Fundus photo
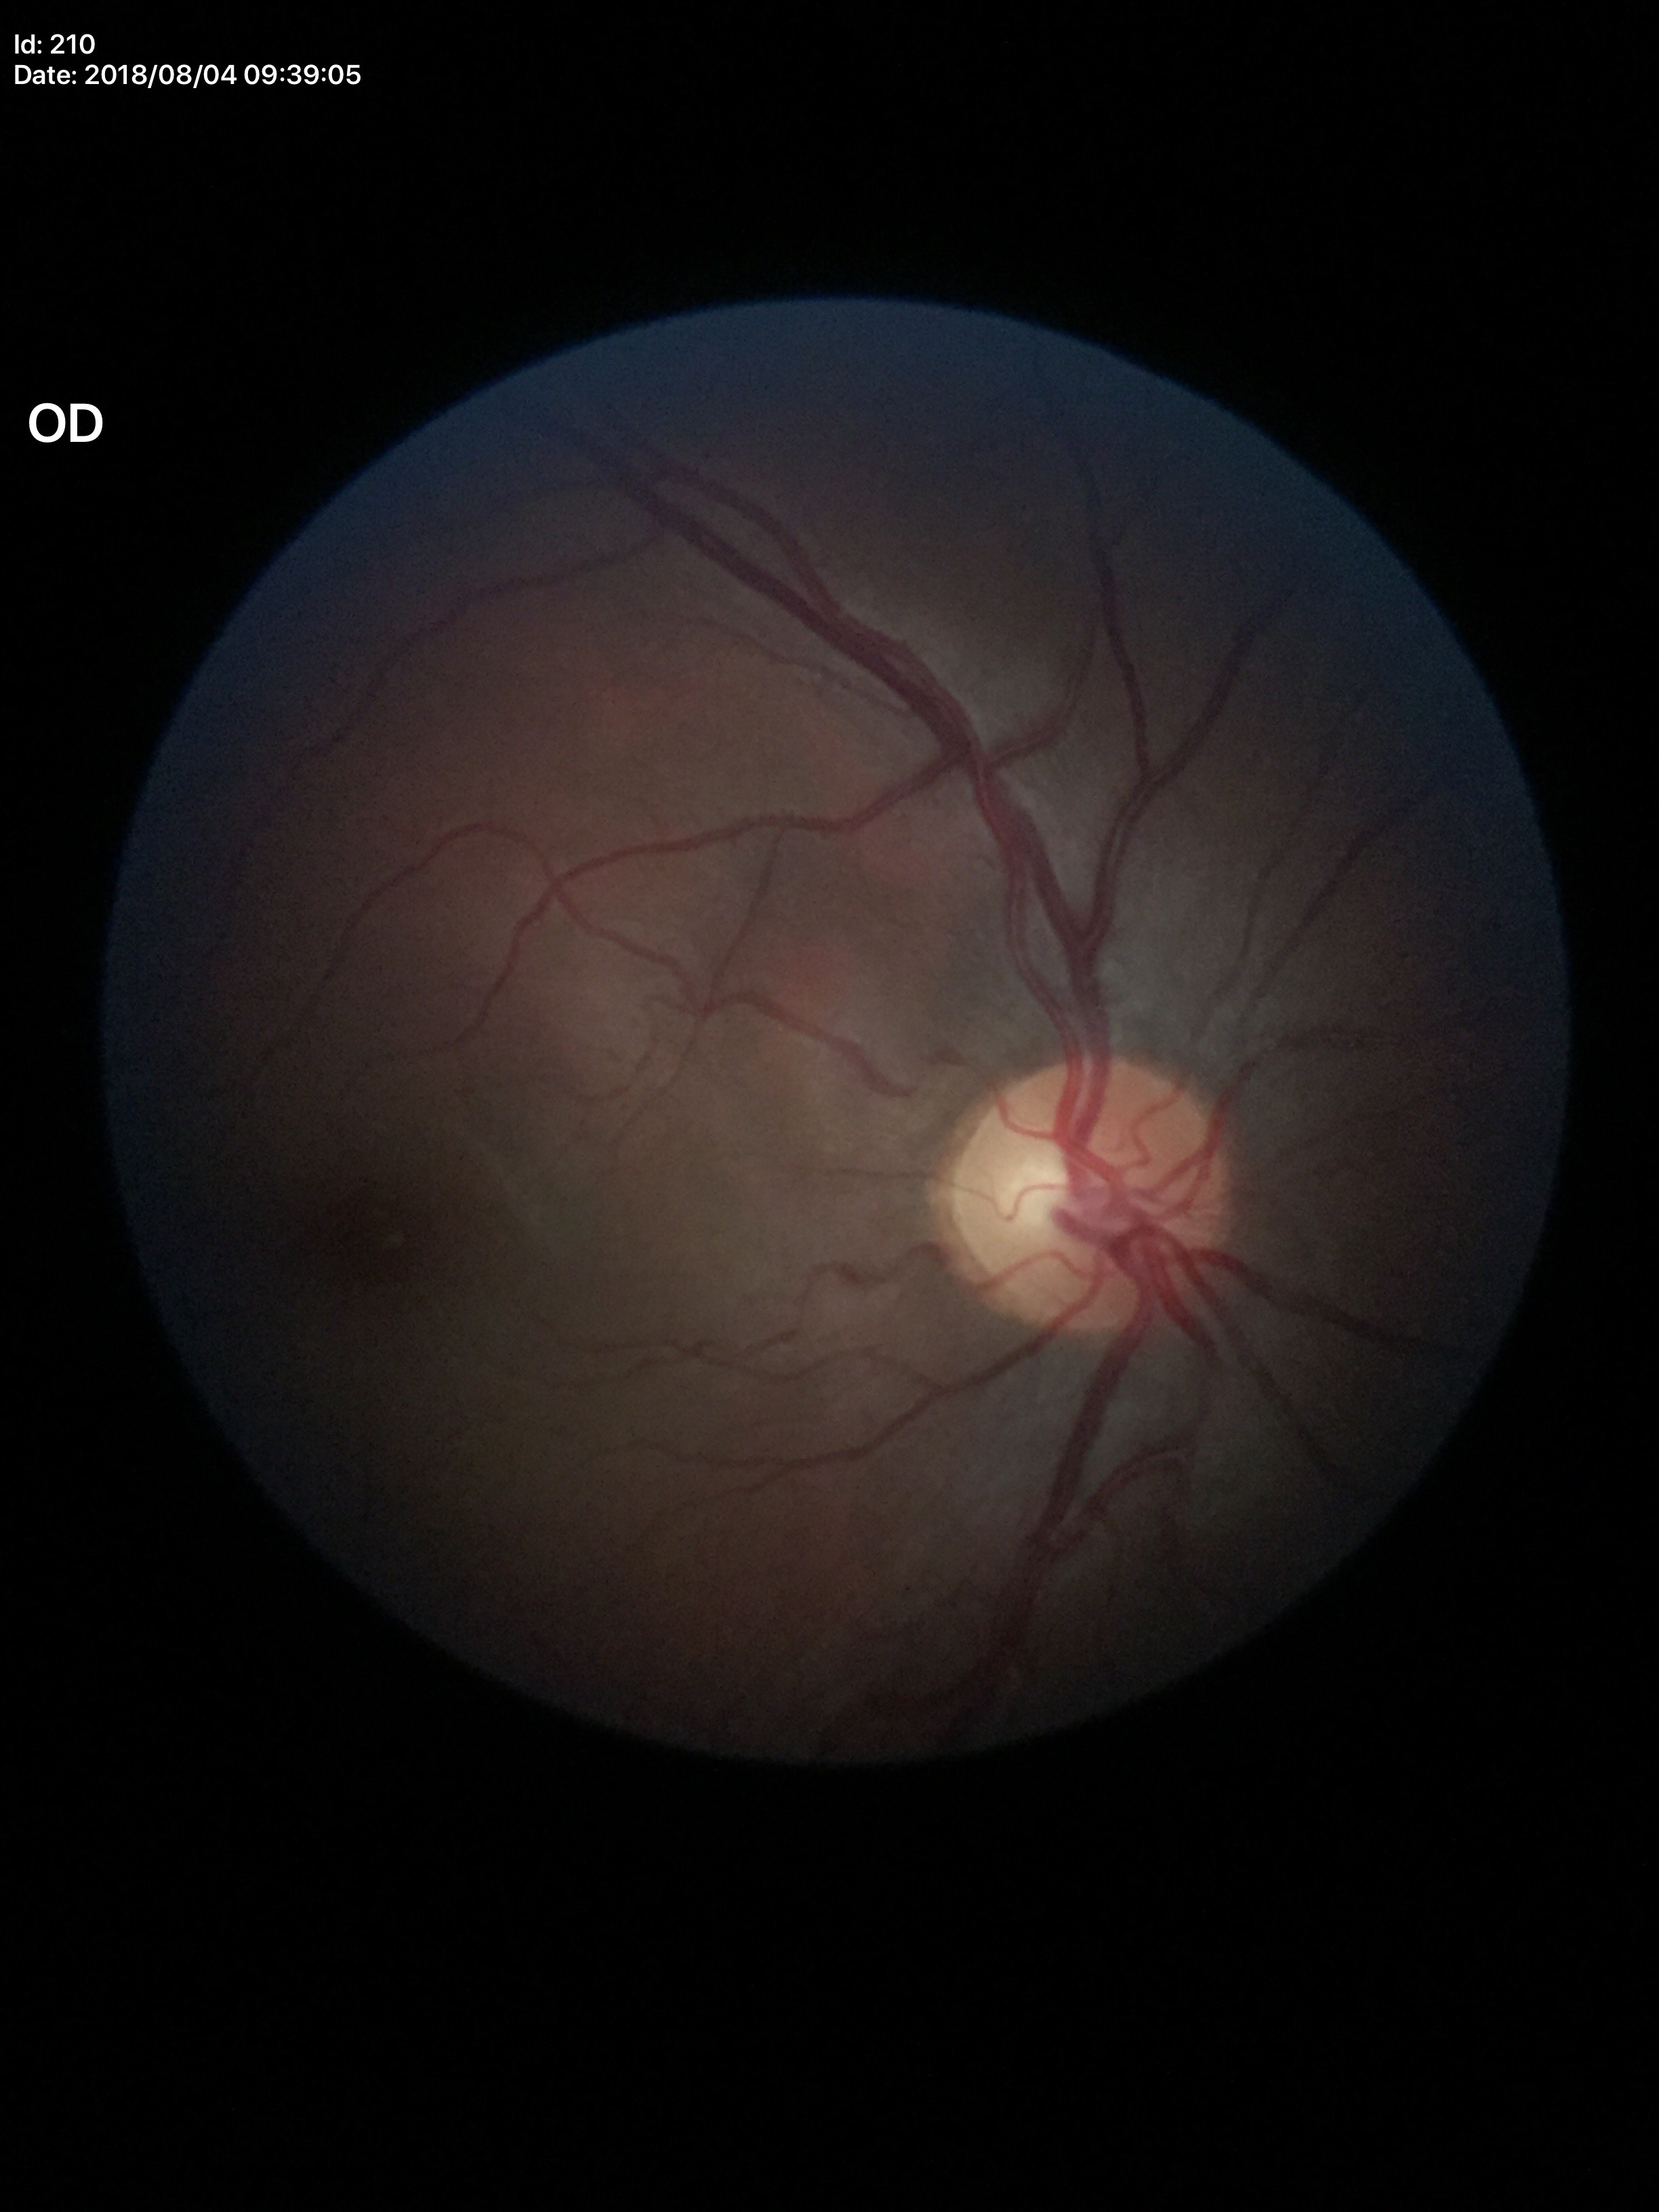
Optic disc analysis:
- vertical cup-to-disc ratio — 0.54
- horizontal cup-disc ratio — 0.59
- Glaucoma screening impression — not suspect (1/5 graders called glaucoma suspect)